Color fundus image: 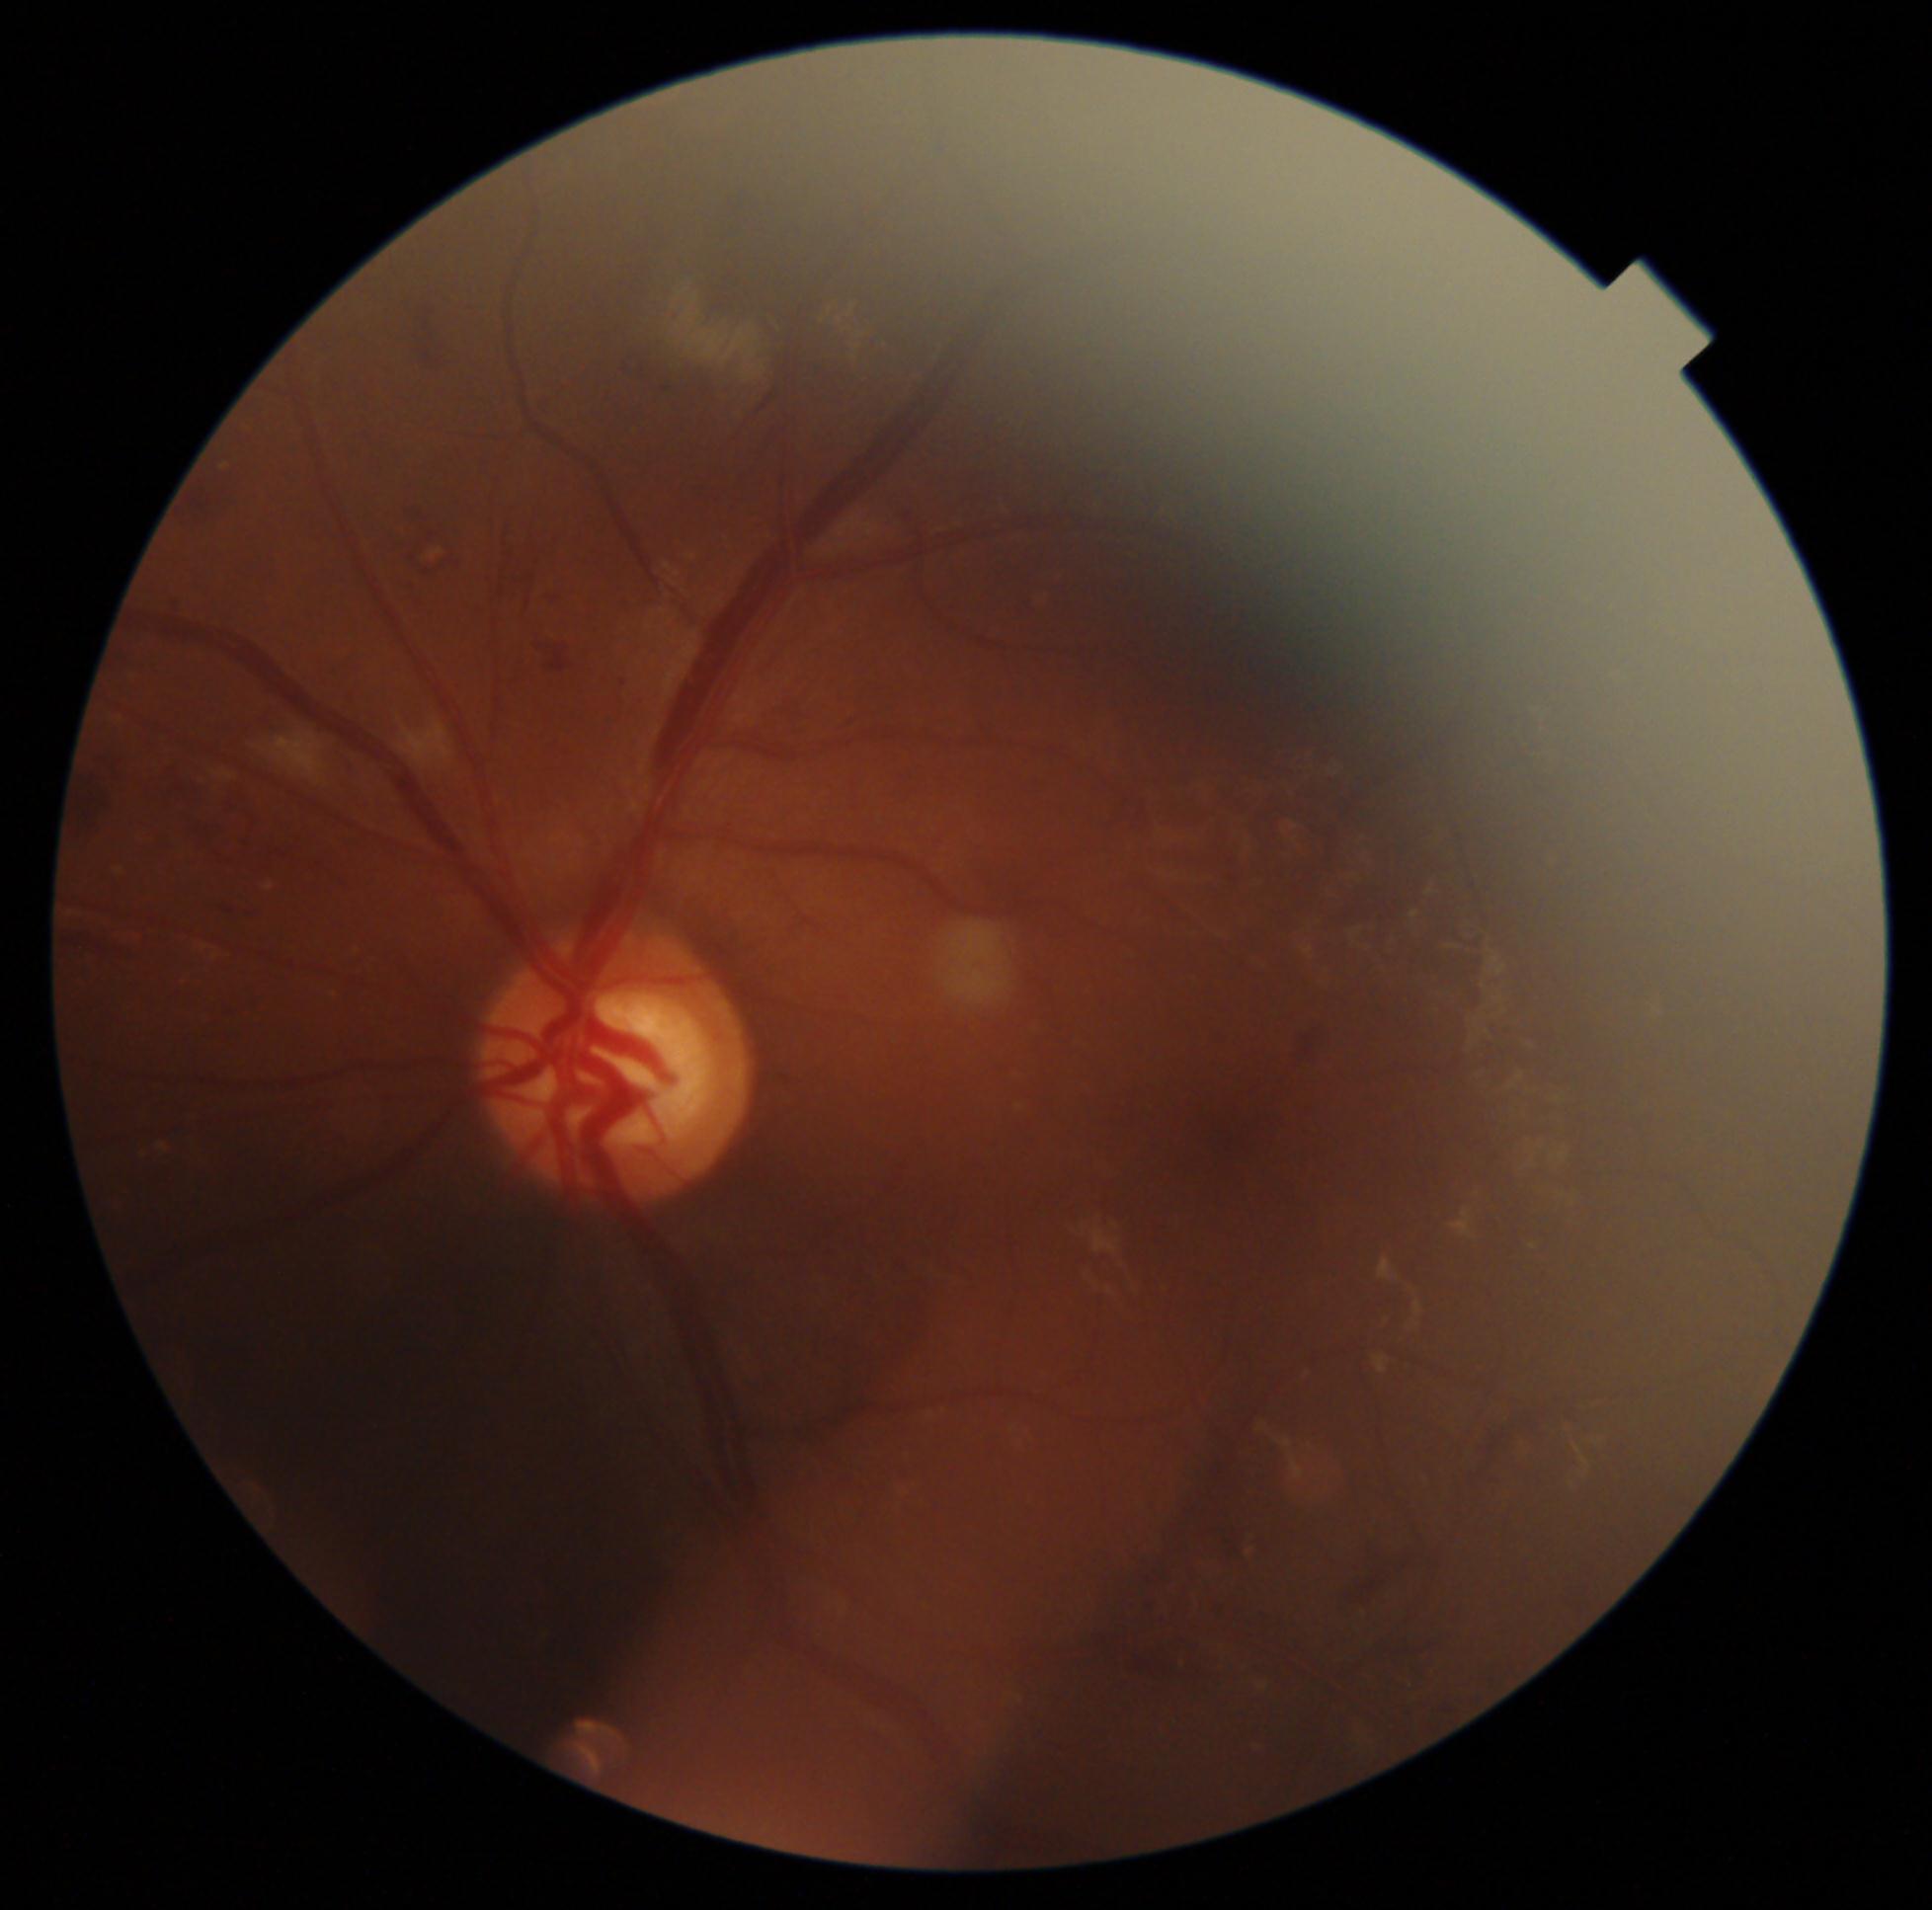 dr_grade: moderate non-proliferative diabetic retinopathy (2)